Color fundus image
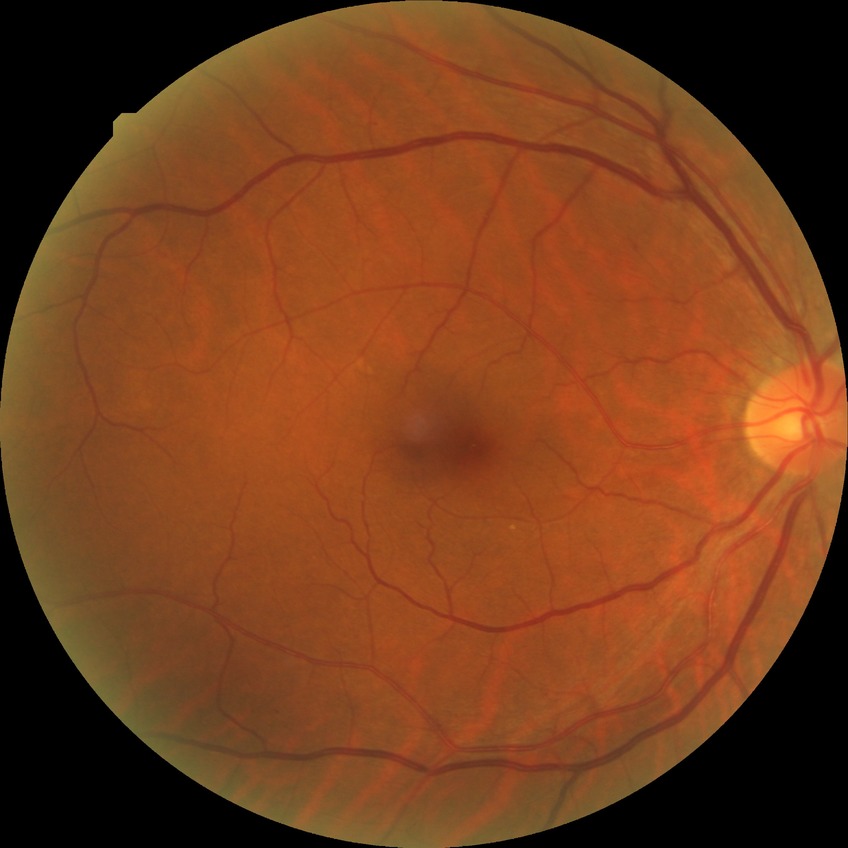 Assessment:
* retinopathy grade — no diabetic retinopathy